2352 by 1568 pixels · color fundus photograph:
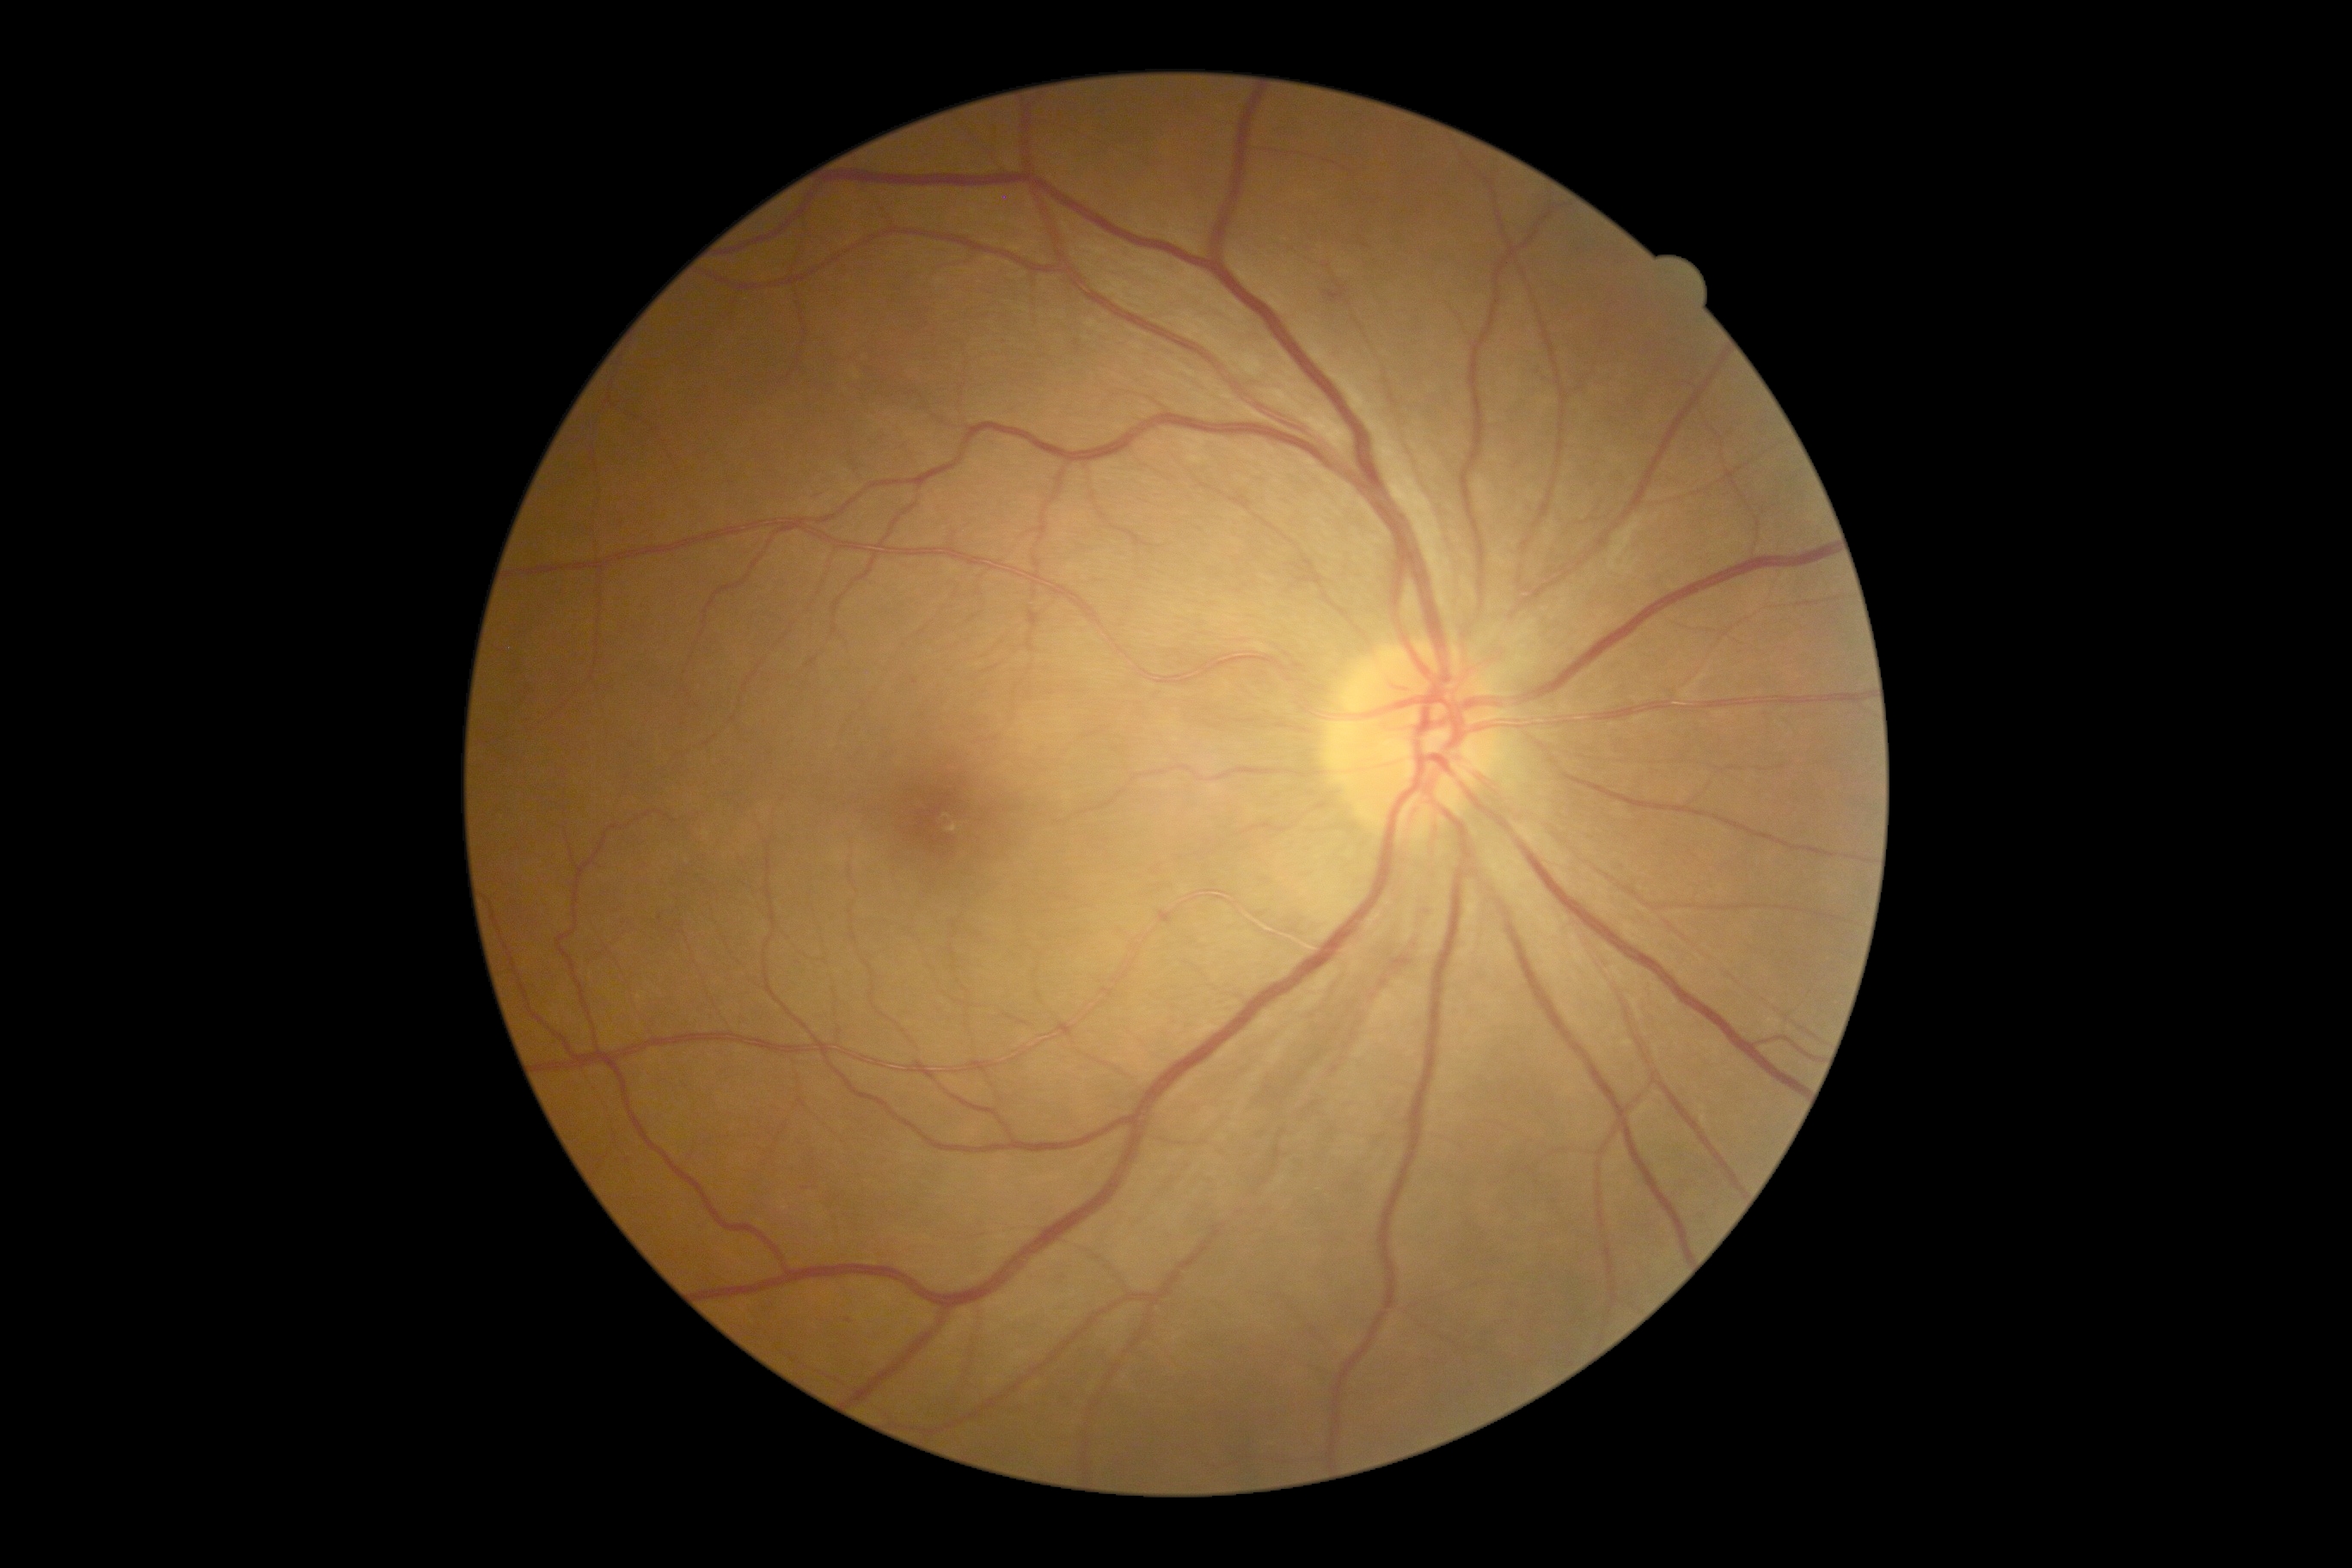
dr_grade: mild non-proliferative diabetic retinopathy (1) — presence of microaneurysms only